Camera: NIDEK AFC-230
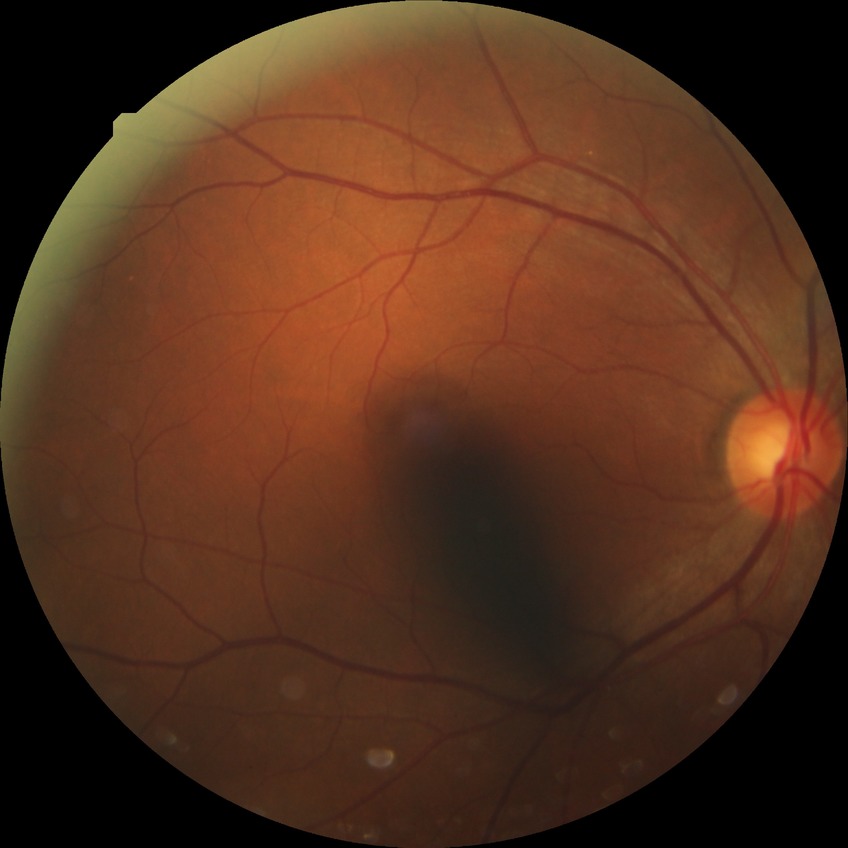 diabetic retinopathy severity = no diabetic retinopathy